848x848px; color fundus photograph; 45° field of view.
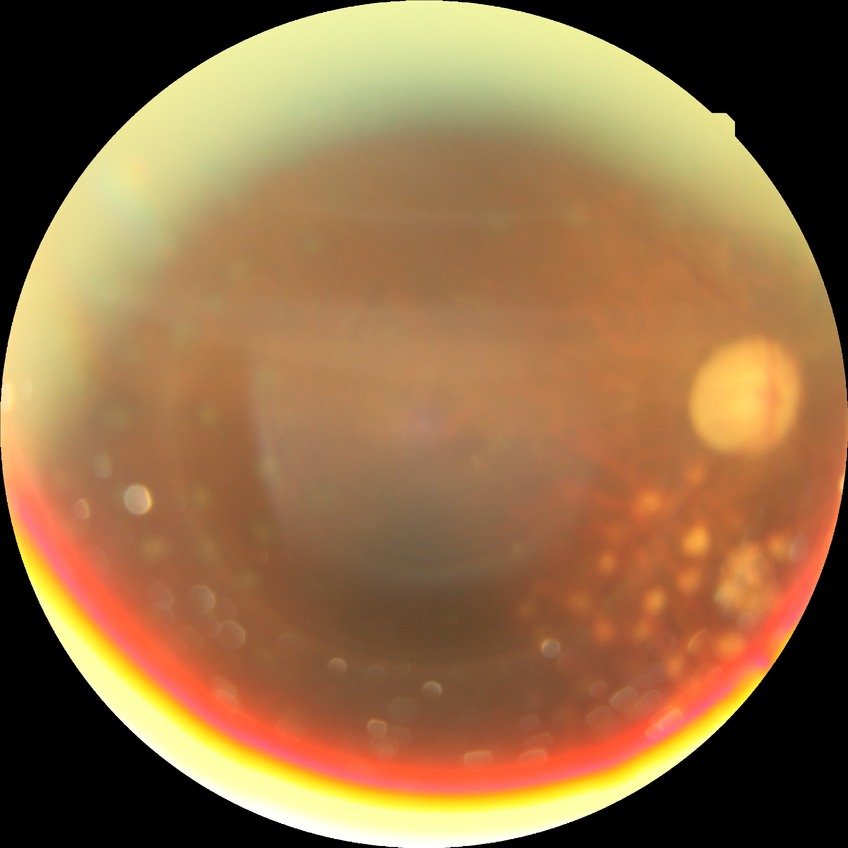

Diabetic retinopathy (DR) is proliferative diabetic retinopathy (PDR).